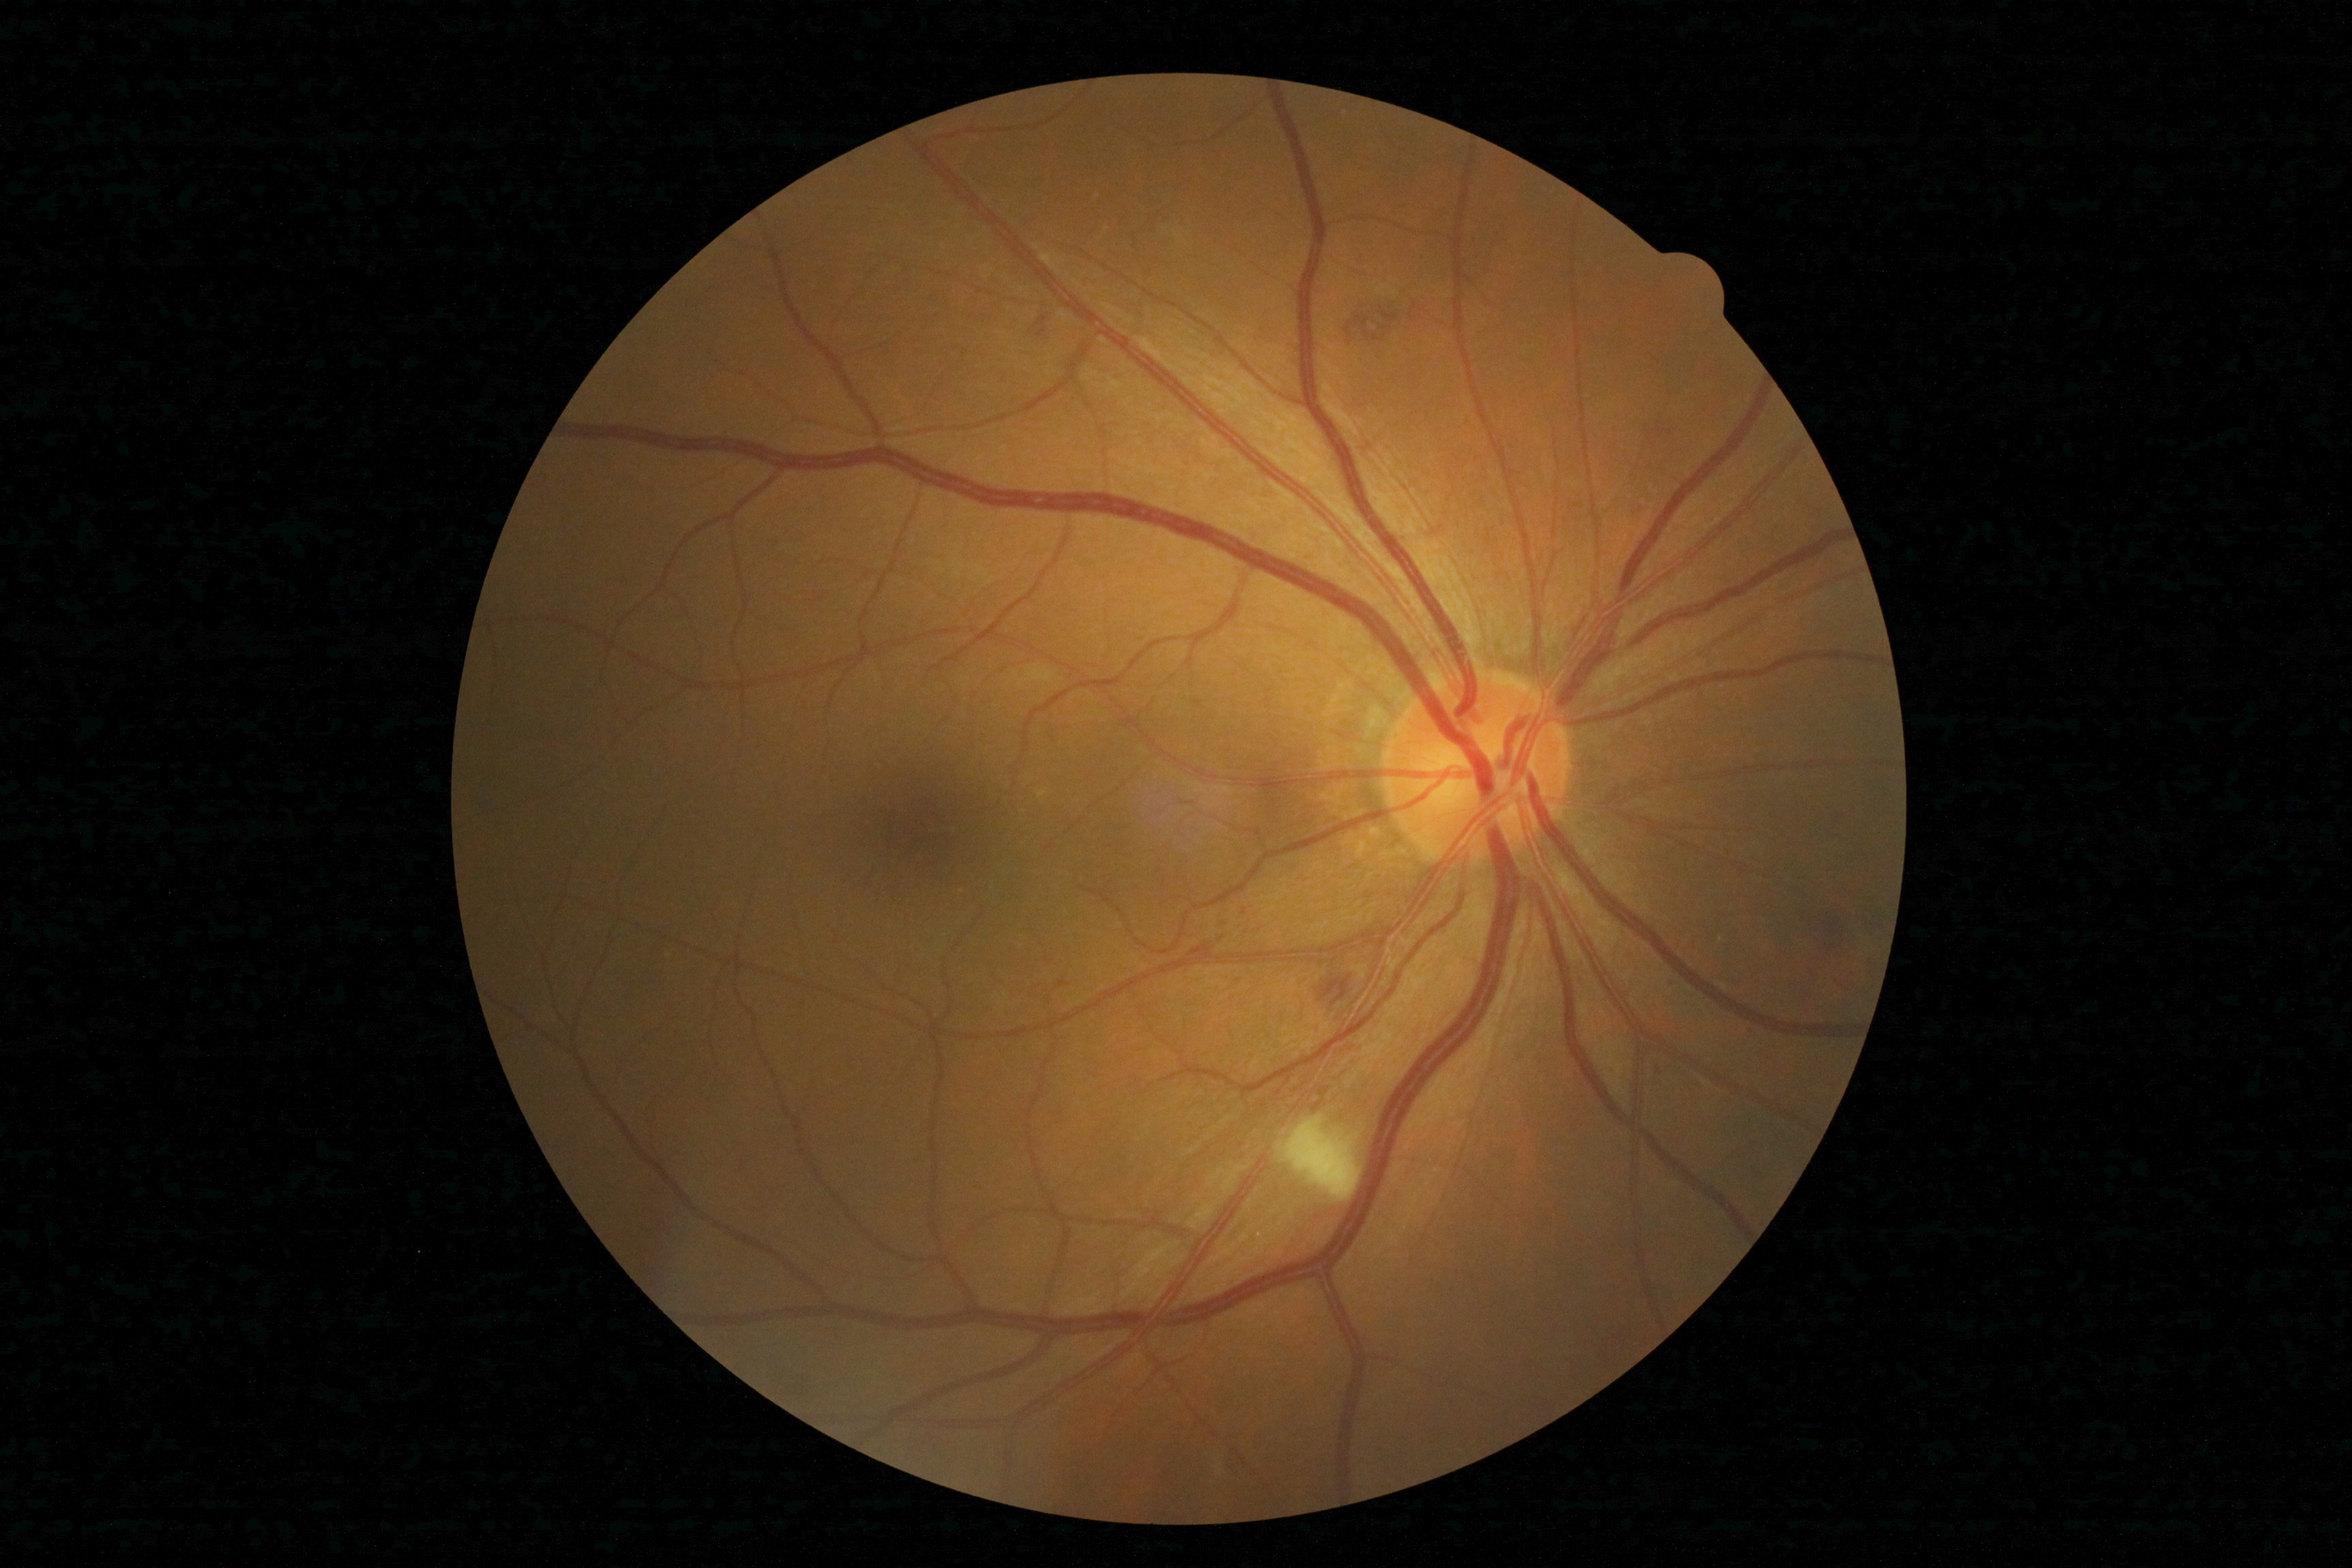 DR grade is 2/4.